1932 by 1910 pixels.
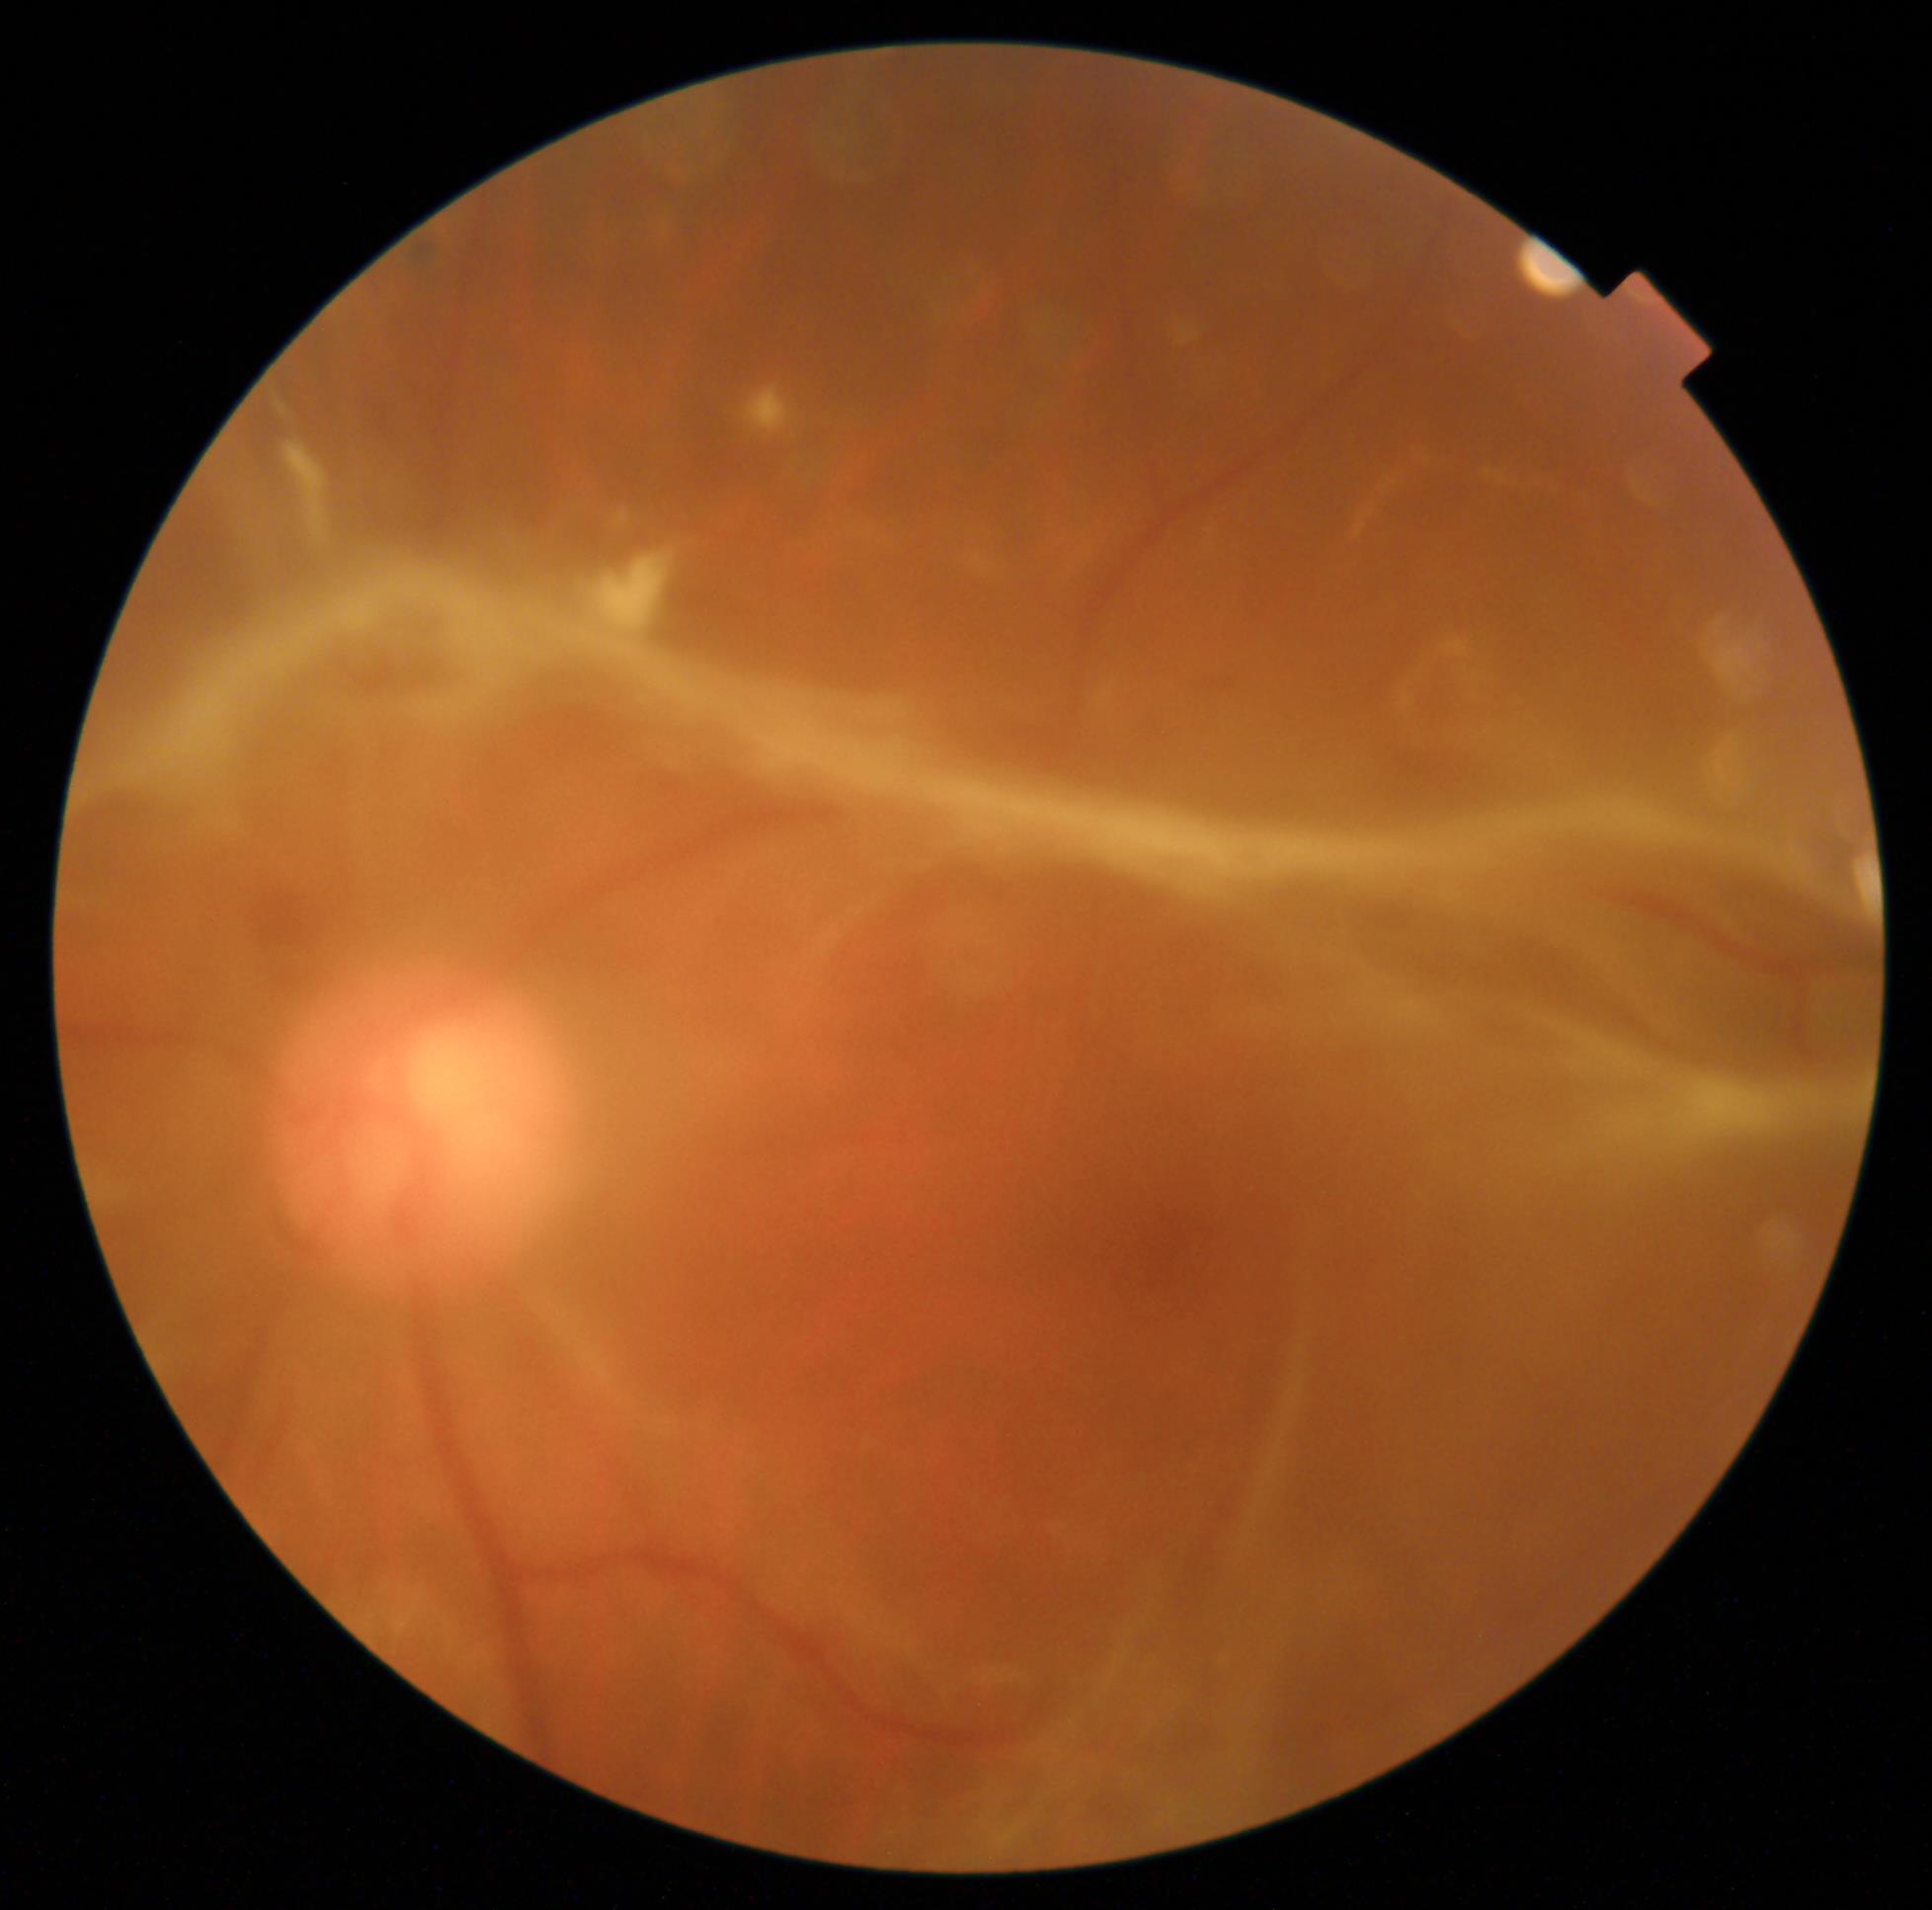

Diabetic retinopathy (DR) is grade 4 — neovascularization and/or vitreous/pre-retinal hemorrhage.
The retinopathy is classified as proliferative diabetic retinopathy.